FOV: 45 degrees. Image size 2048x1536
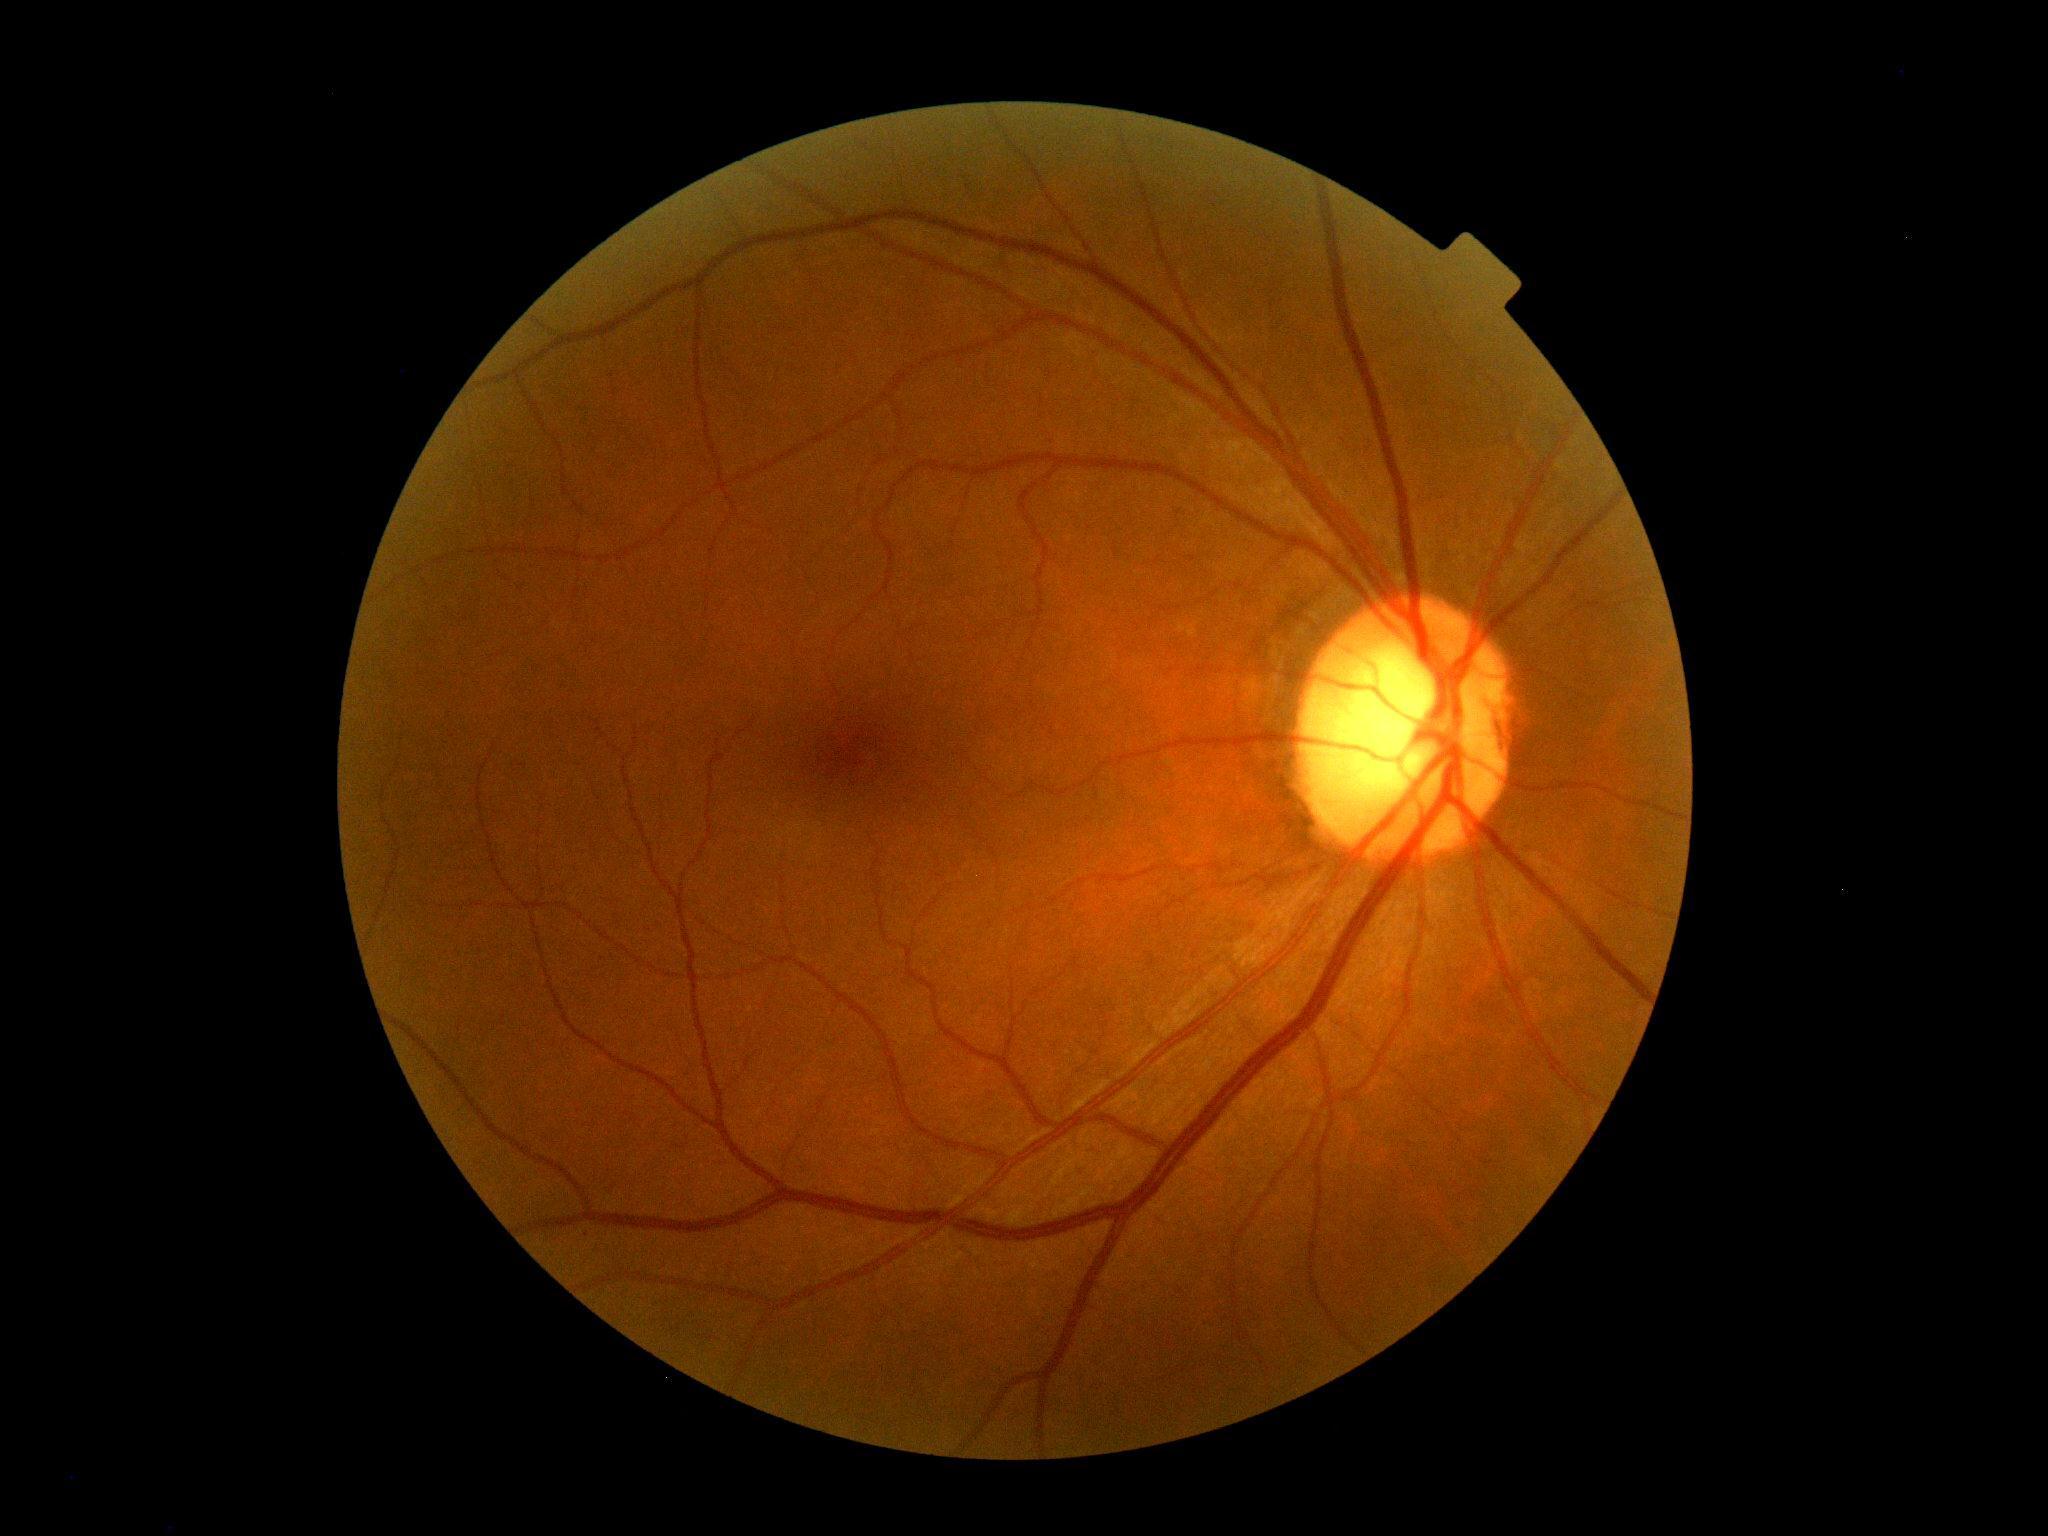

{"dr_grade": "grade 0"}